848x848px. Nonmydriatic fundus photograph
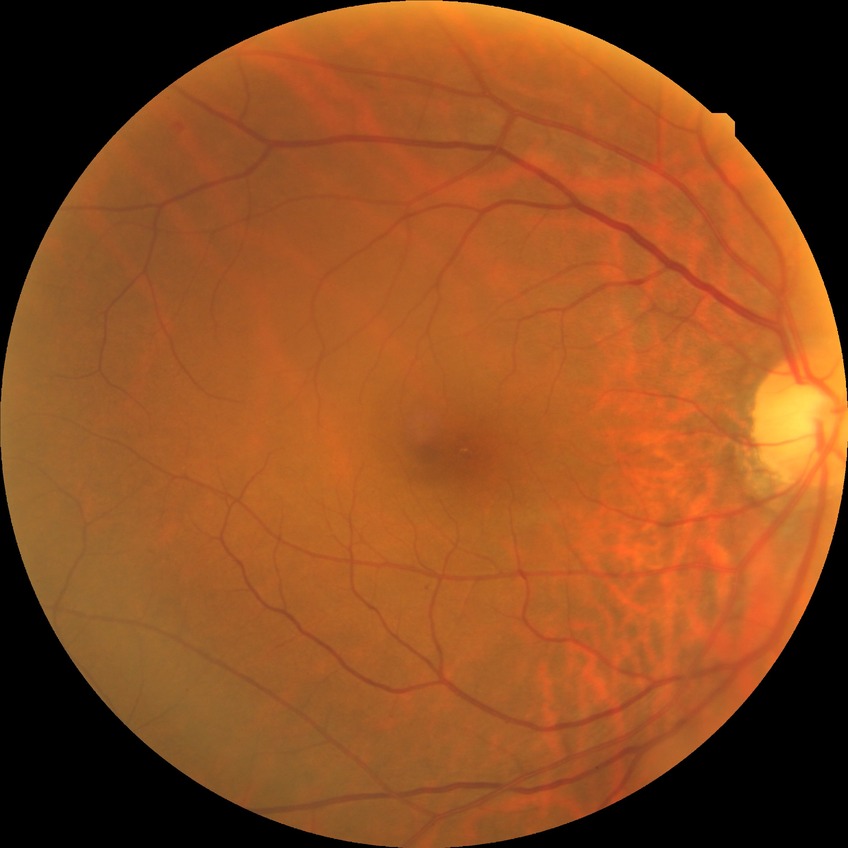 Diabetic retinopathy (DR) is NDR (no diabetic retinopathy).